Fundus photo.
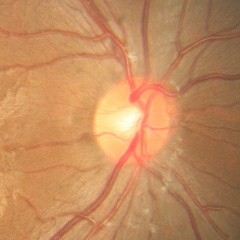
Showing no signs of glaucoma.